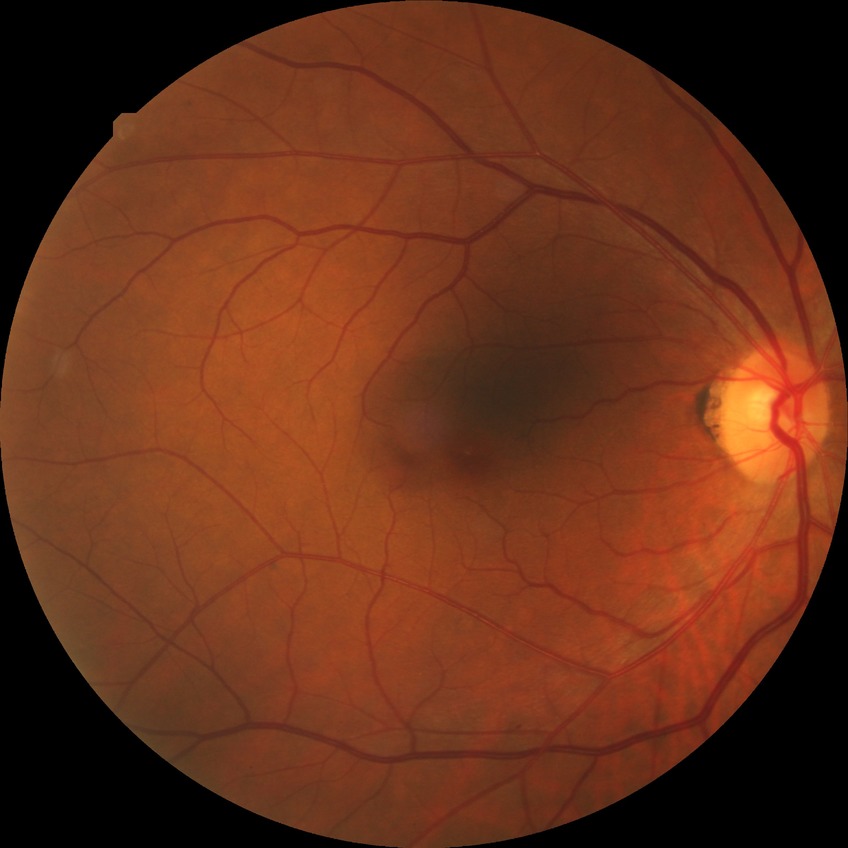
{
  "davis_grade": "simple diabetic retinopathy (SDR)"
}